Modified Davis grading; 848x848; nonmydriatic; 45° field of view; NIDEK AFC-230 fundus camera:
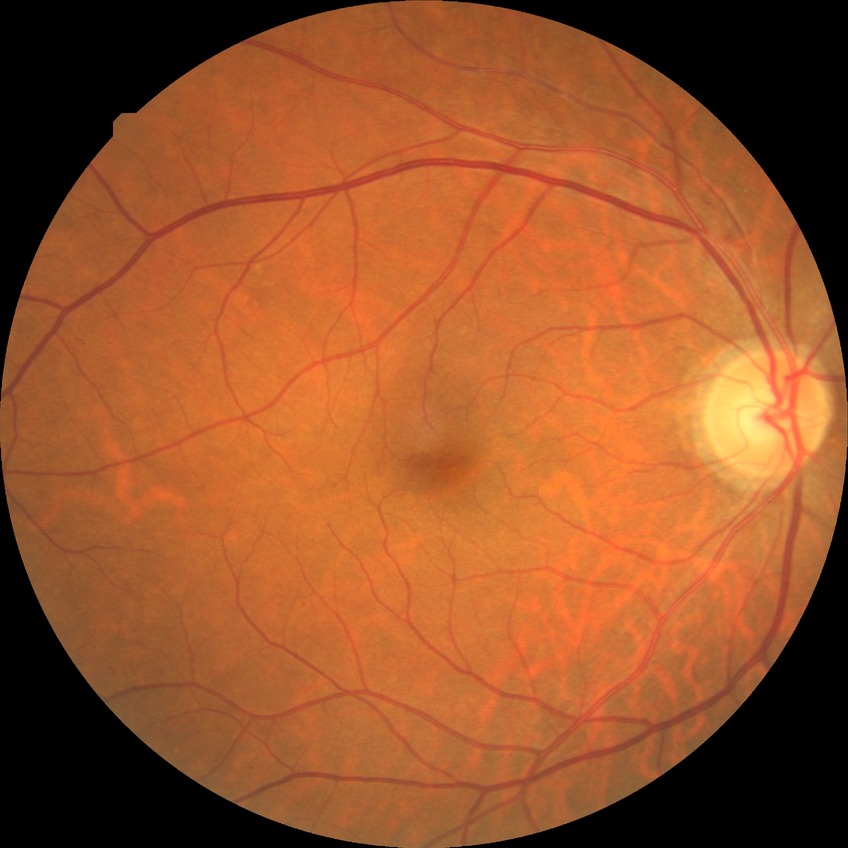
- diabetic retinopathy (DR) — simple diabetic retinopathy (SDR)